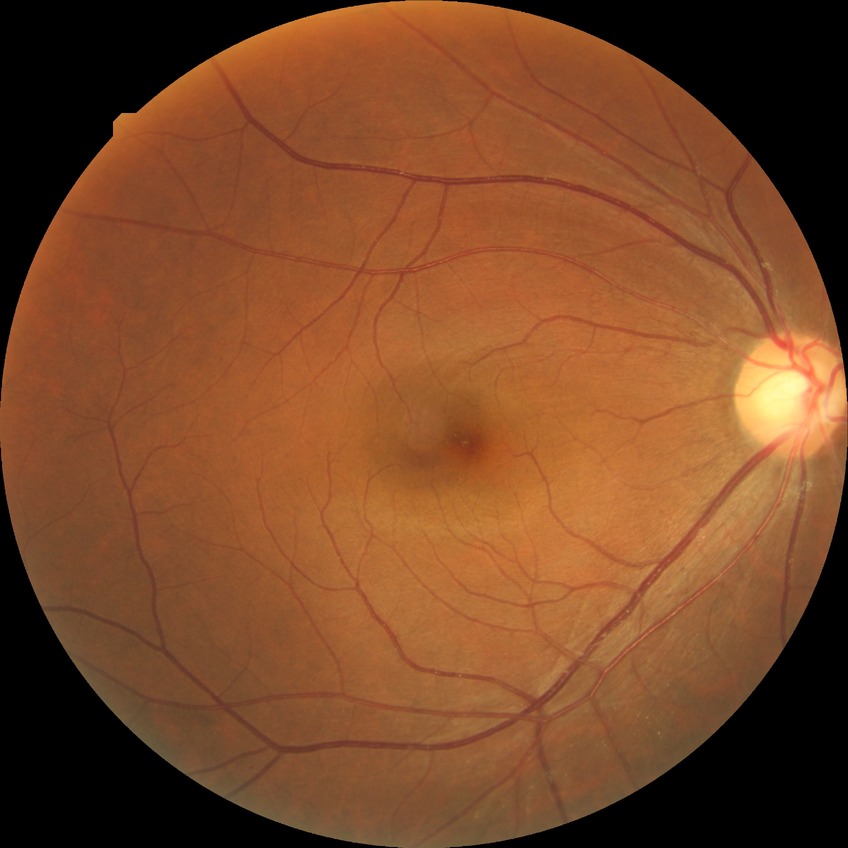 diabetic retinopathy stage: no diabetic retinopathy